CFP
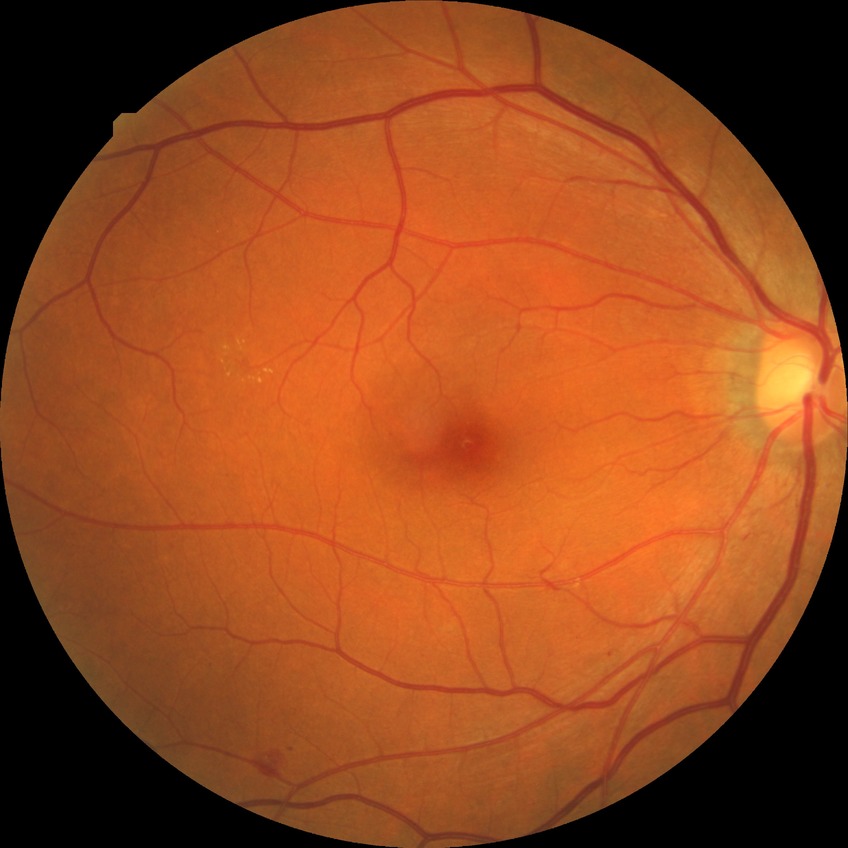 Modified Davis classification: simple diabetic retinopathy.